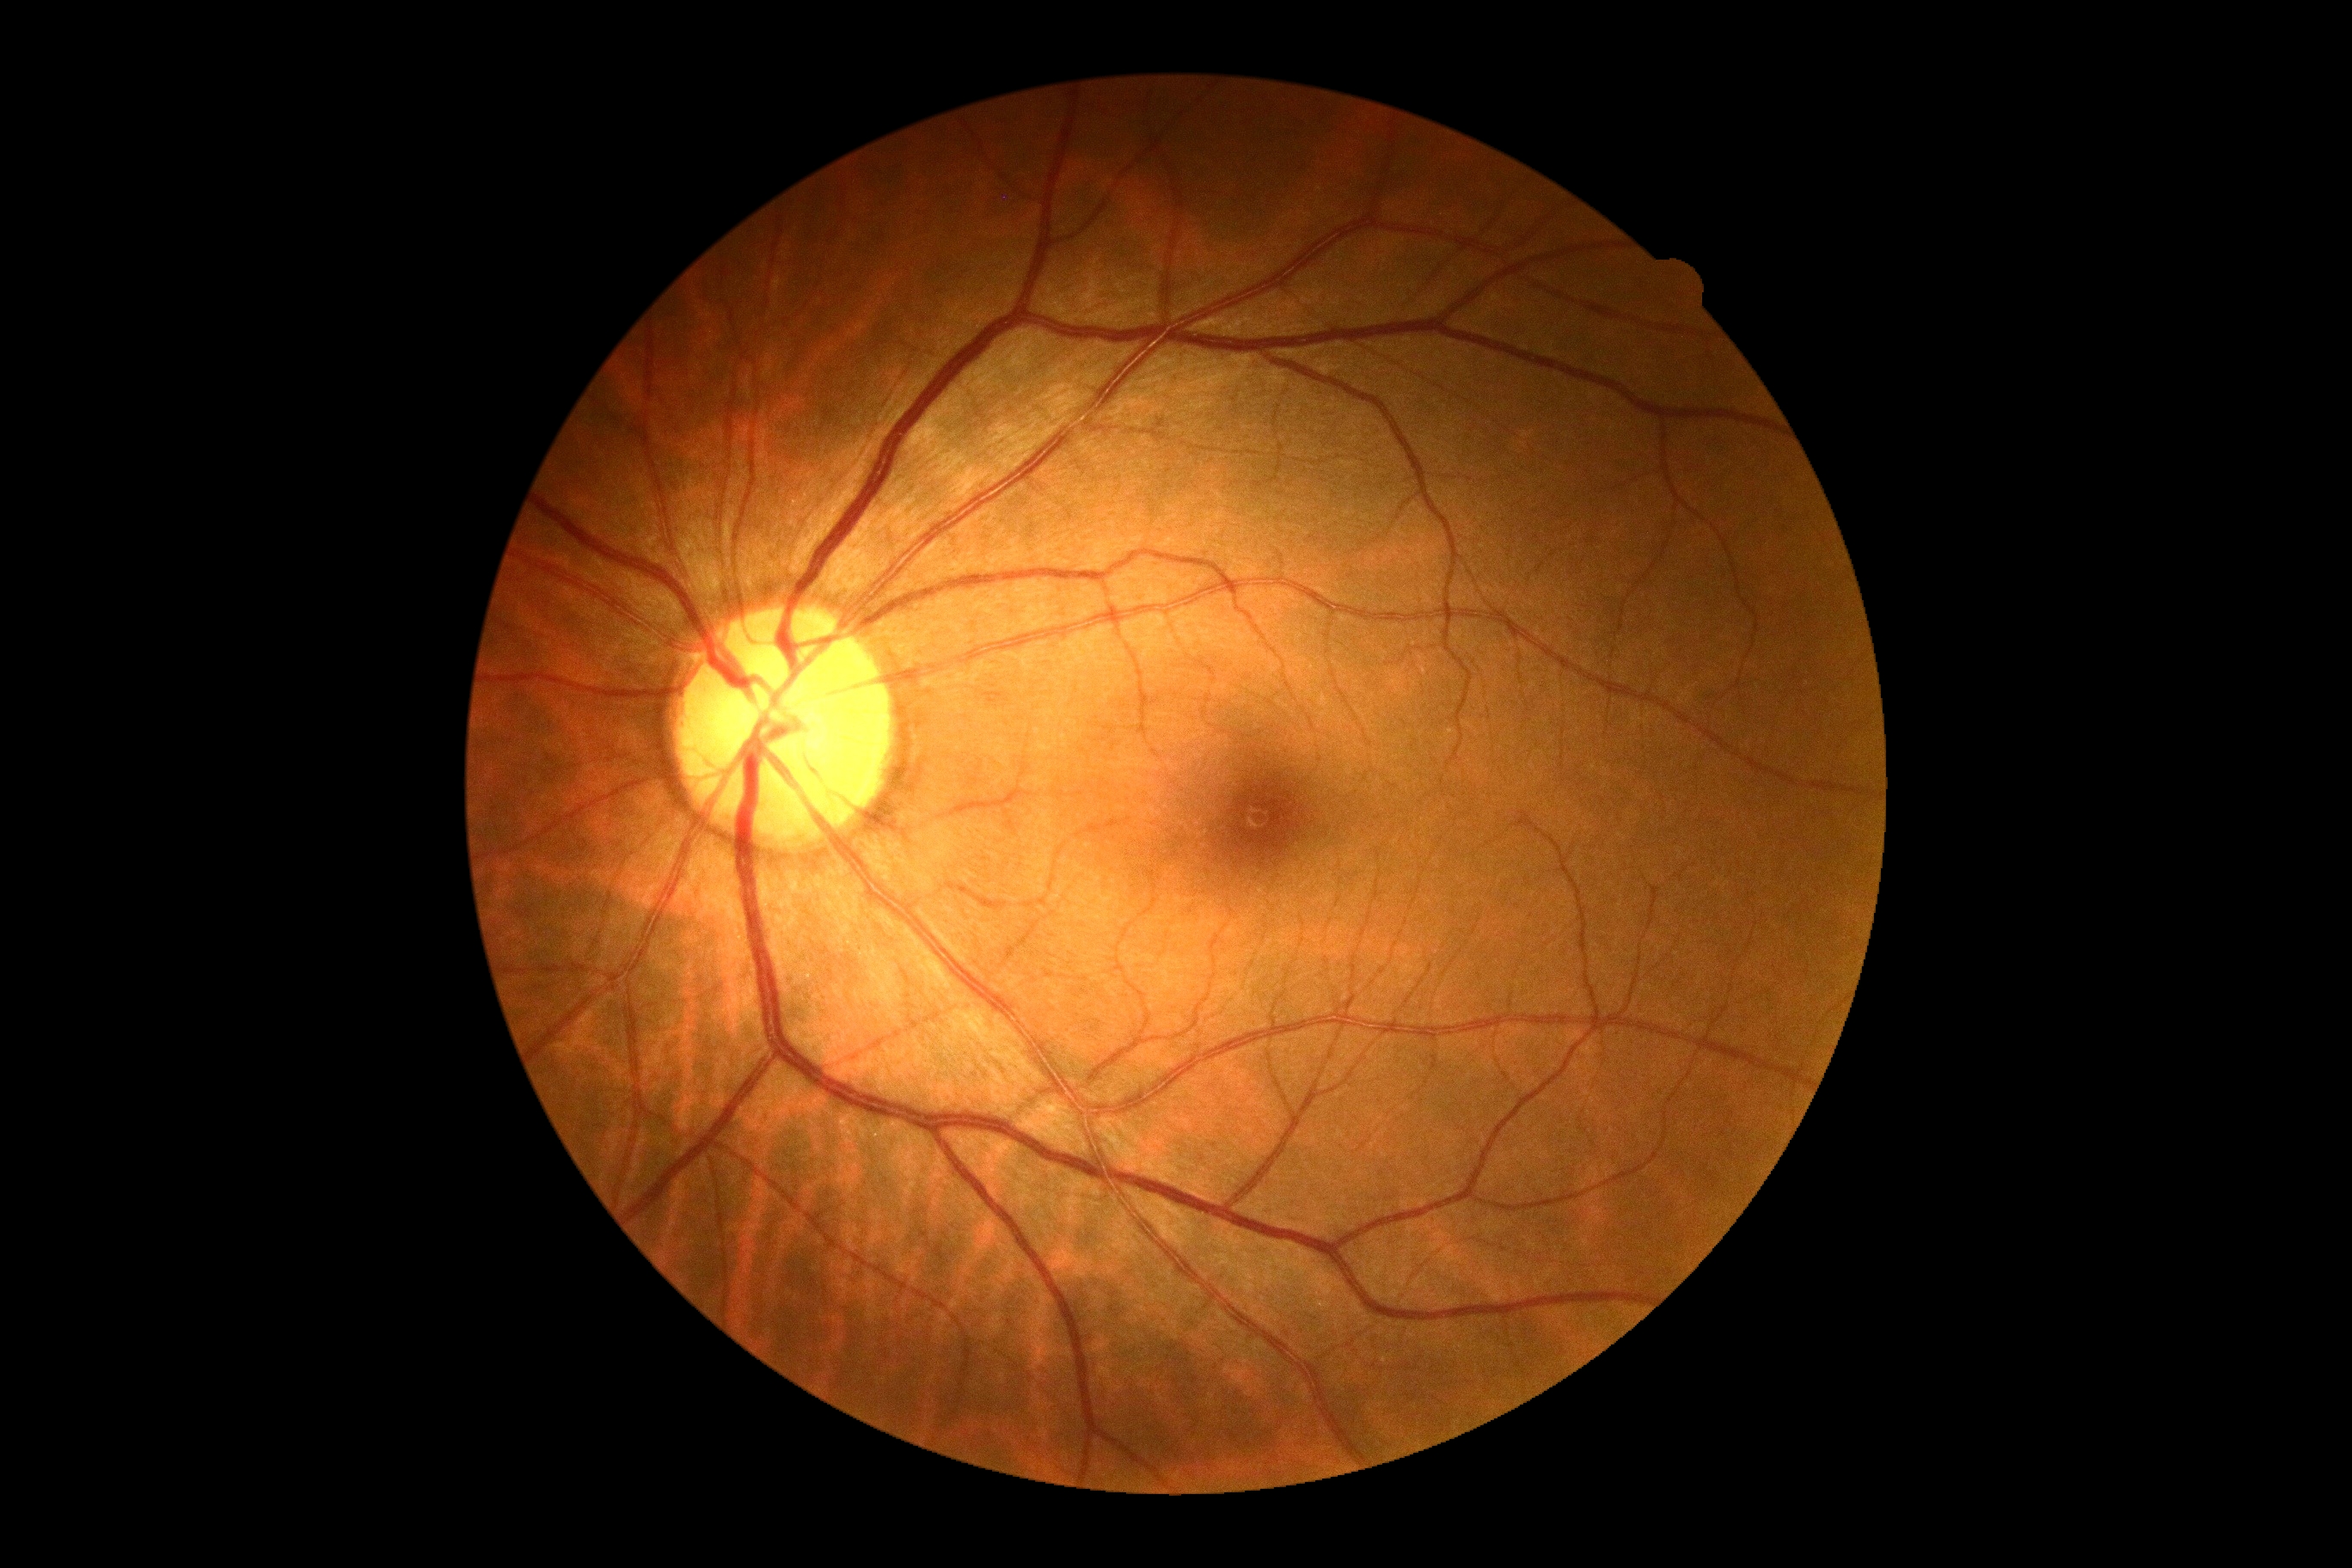

No signs of diabetic retinopathy. DR stage: grade 0.